CFP; 2212x1659px:
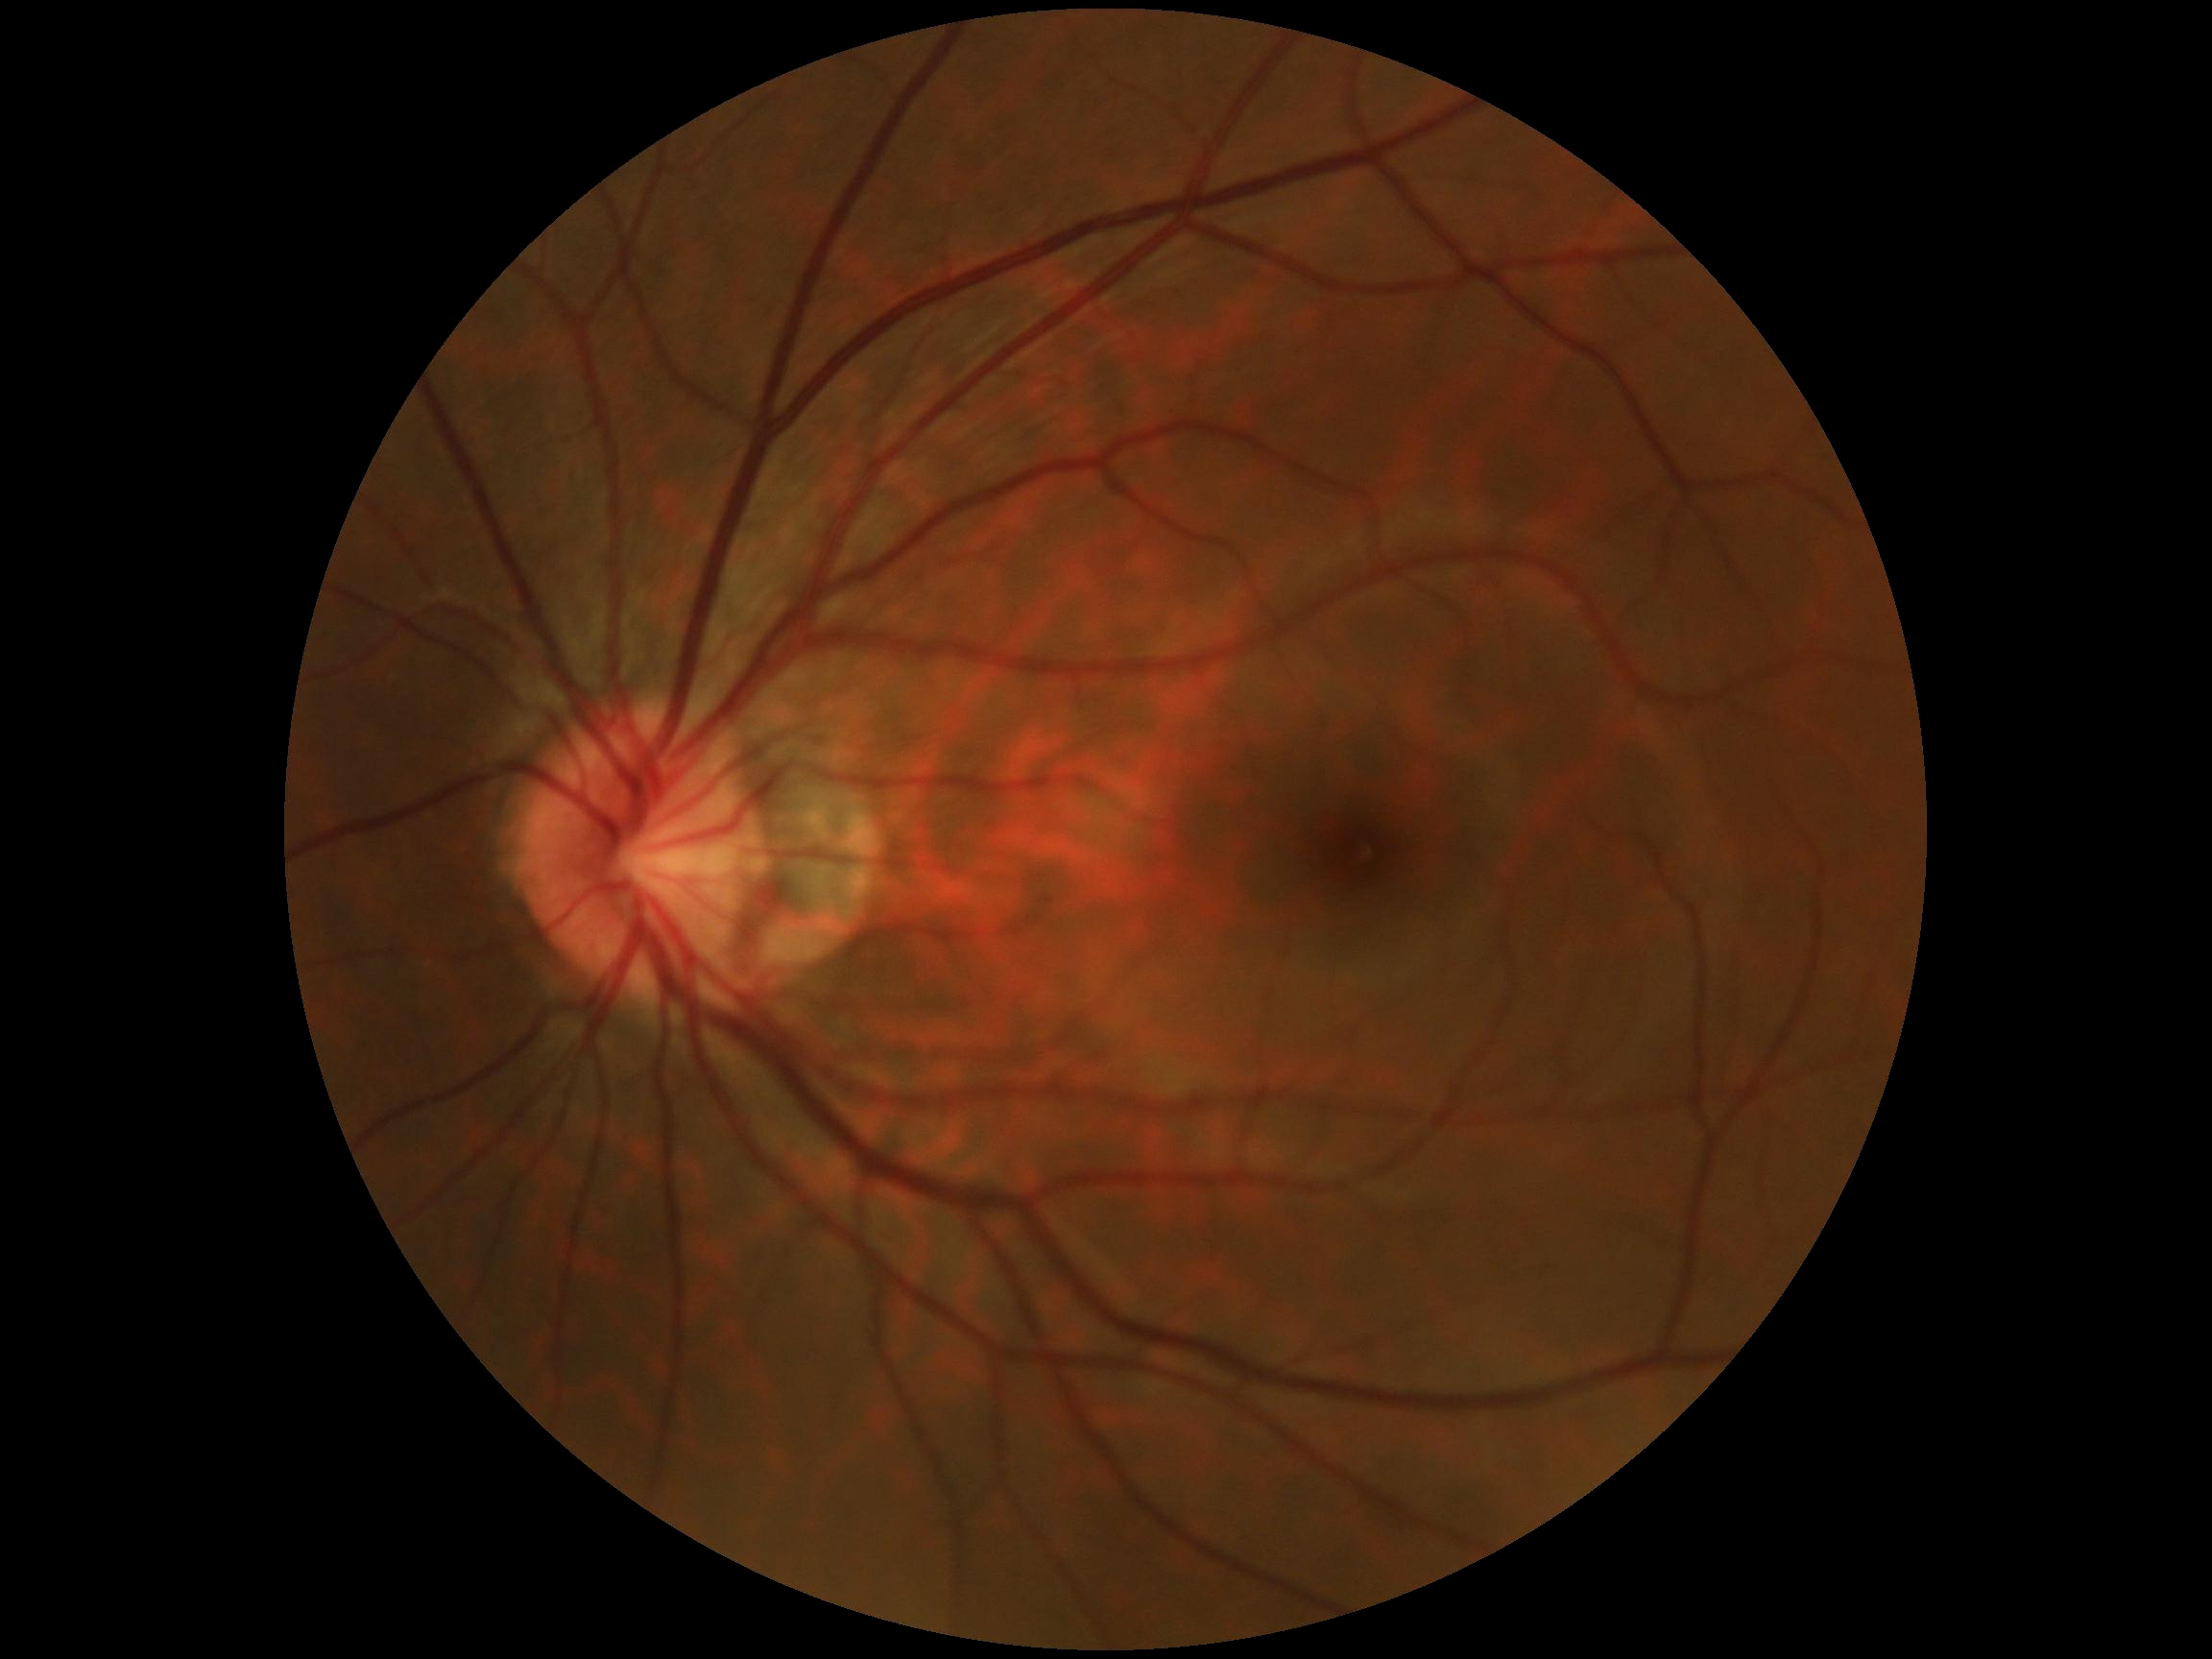

DR grade=no apparent diabetic retinopathy (0) — no visible signs of diabetic retinopathy, DR impression=no DR findings.